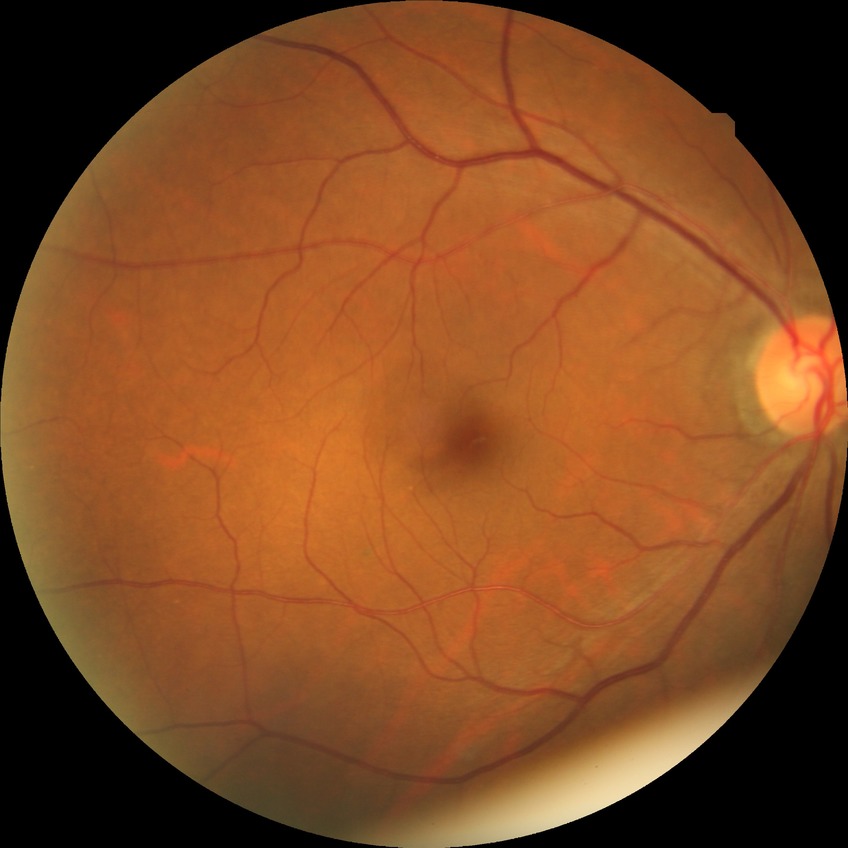 Retinopathy stage is no diabetic retinopathy.